NIDEK AFC-230 fundus camera · diabetic retinopathy graded by the modified Davis classification · color fundus image: 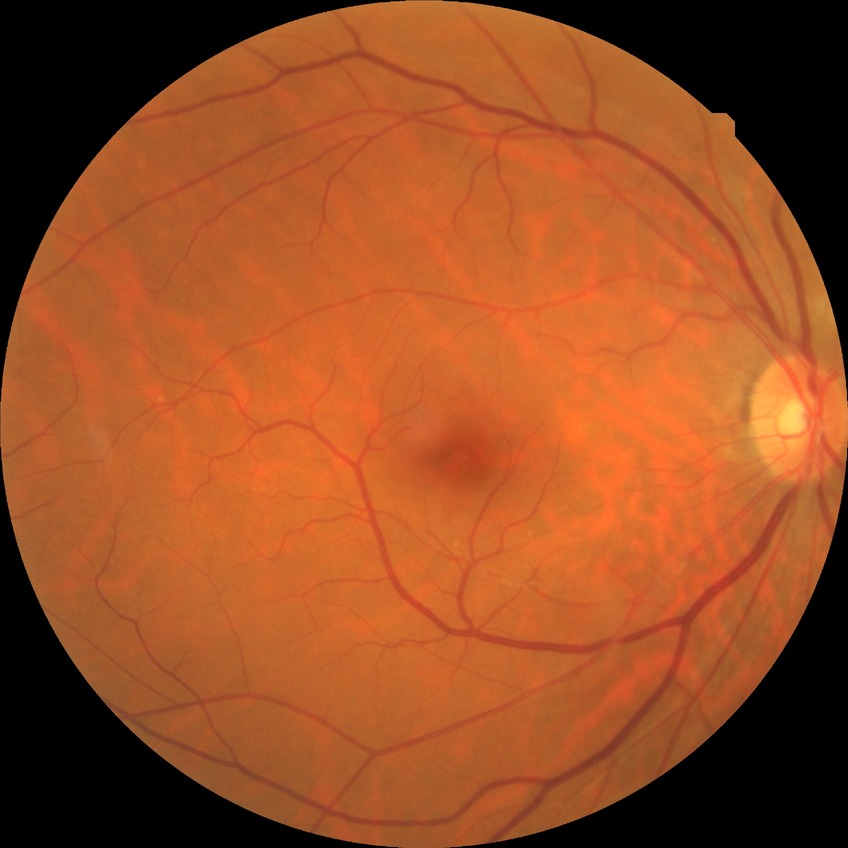
modified Davis grading: no diabetic retinopathy.